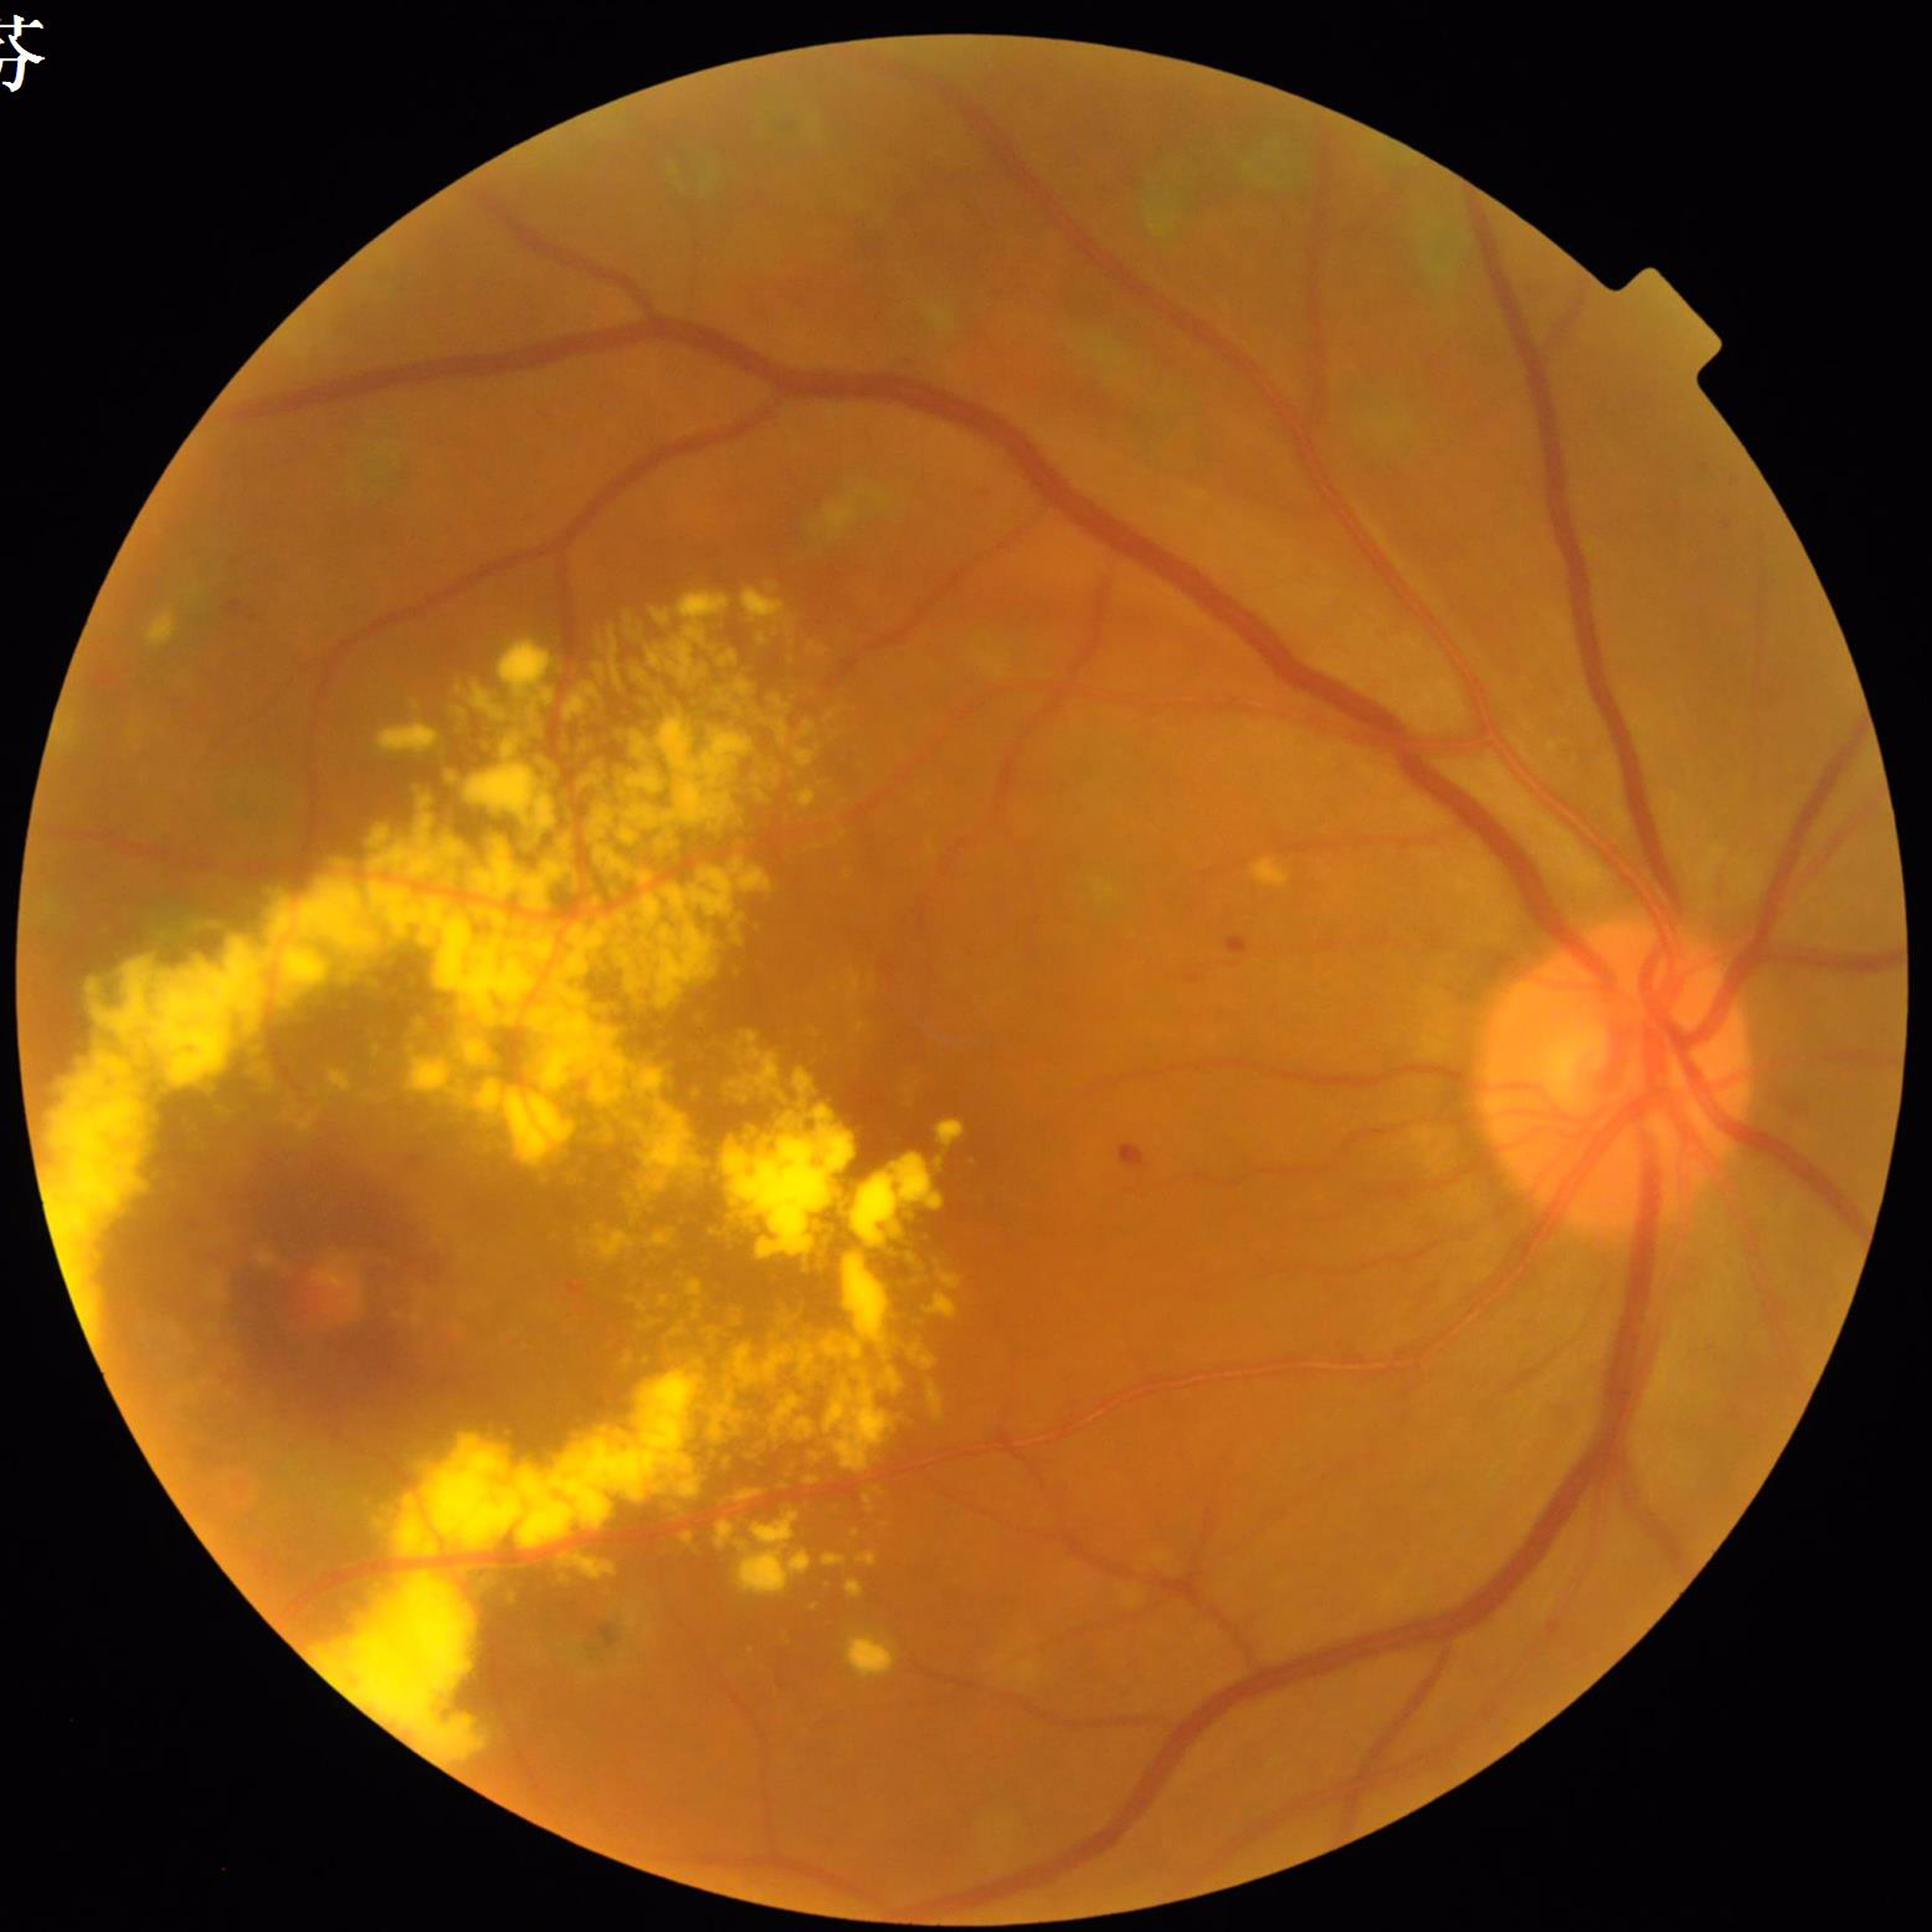
Photo quality: good. Eye affected by diabetic retinopathy (DR).